848x848:
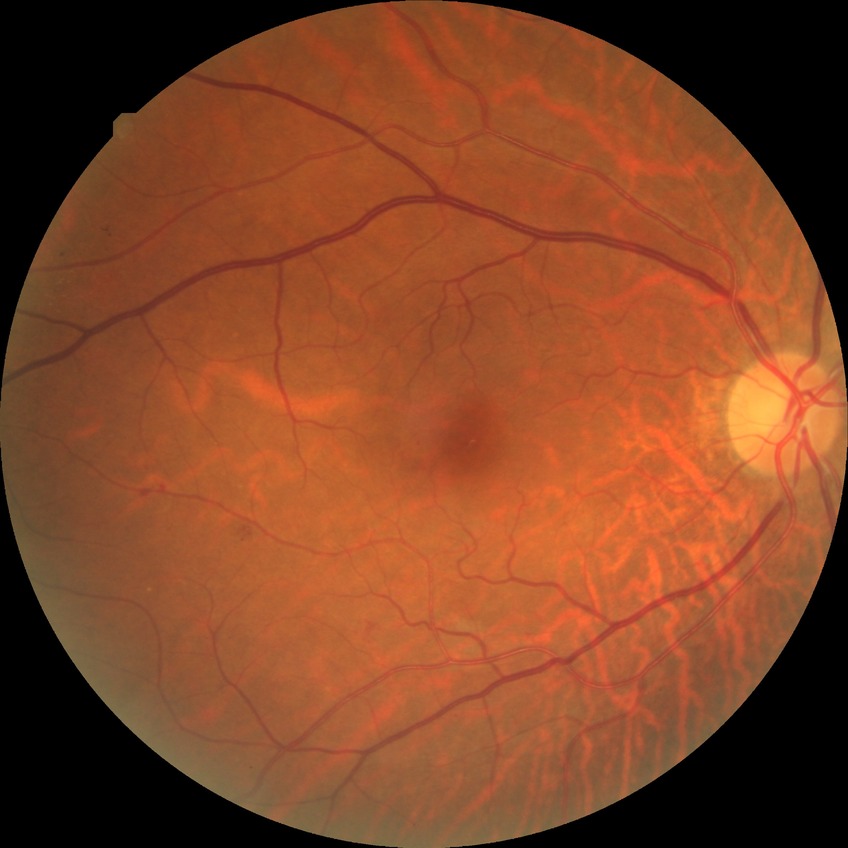 diabetic retinopathy grade: simple diabetic retinopathy.